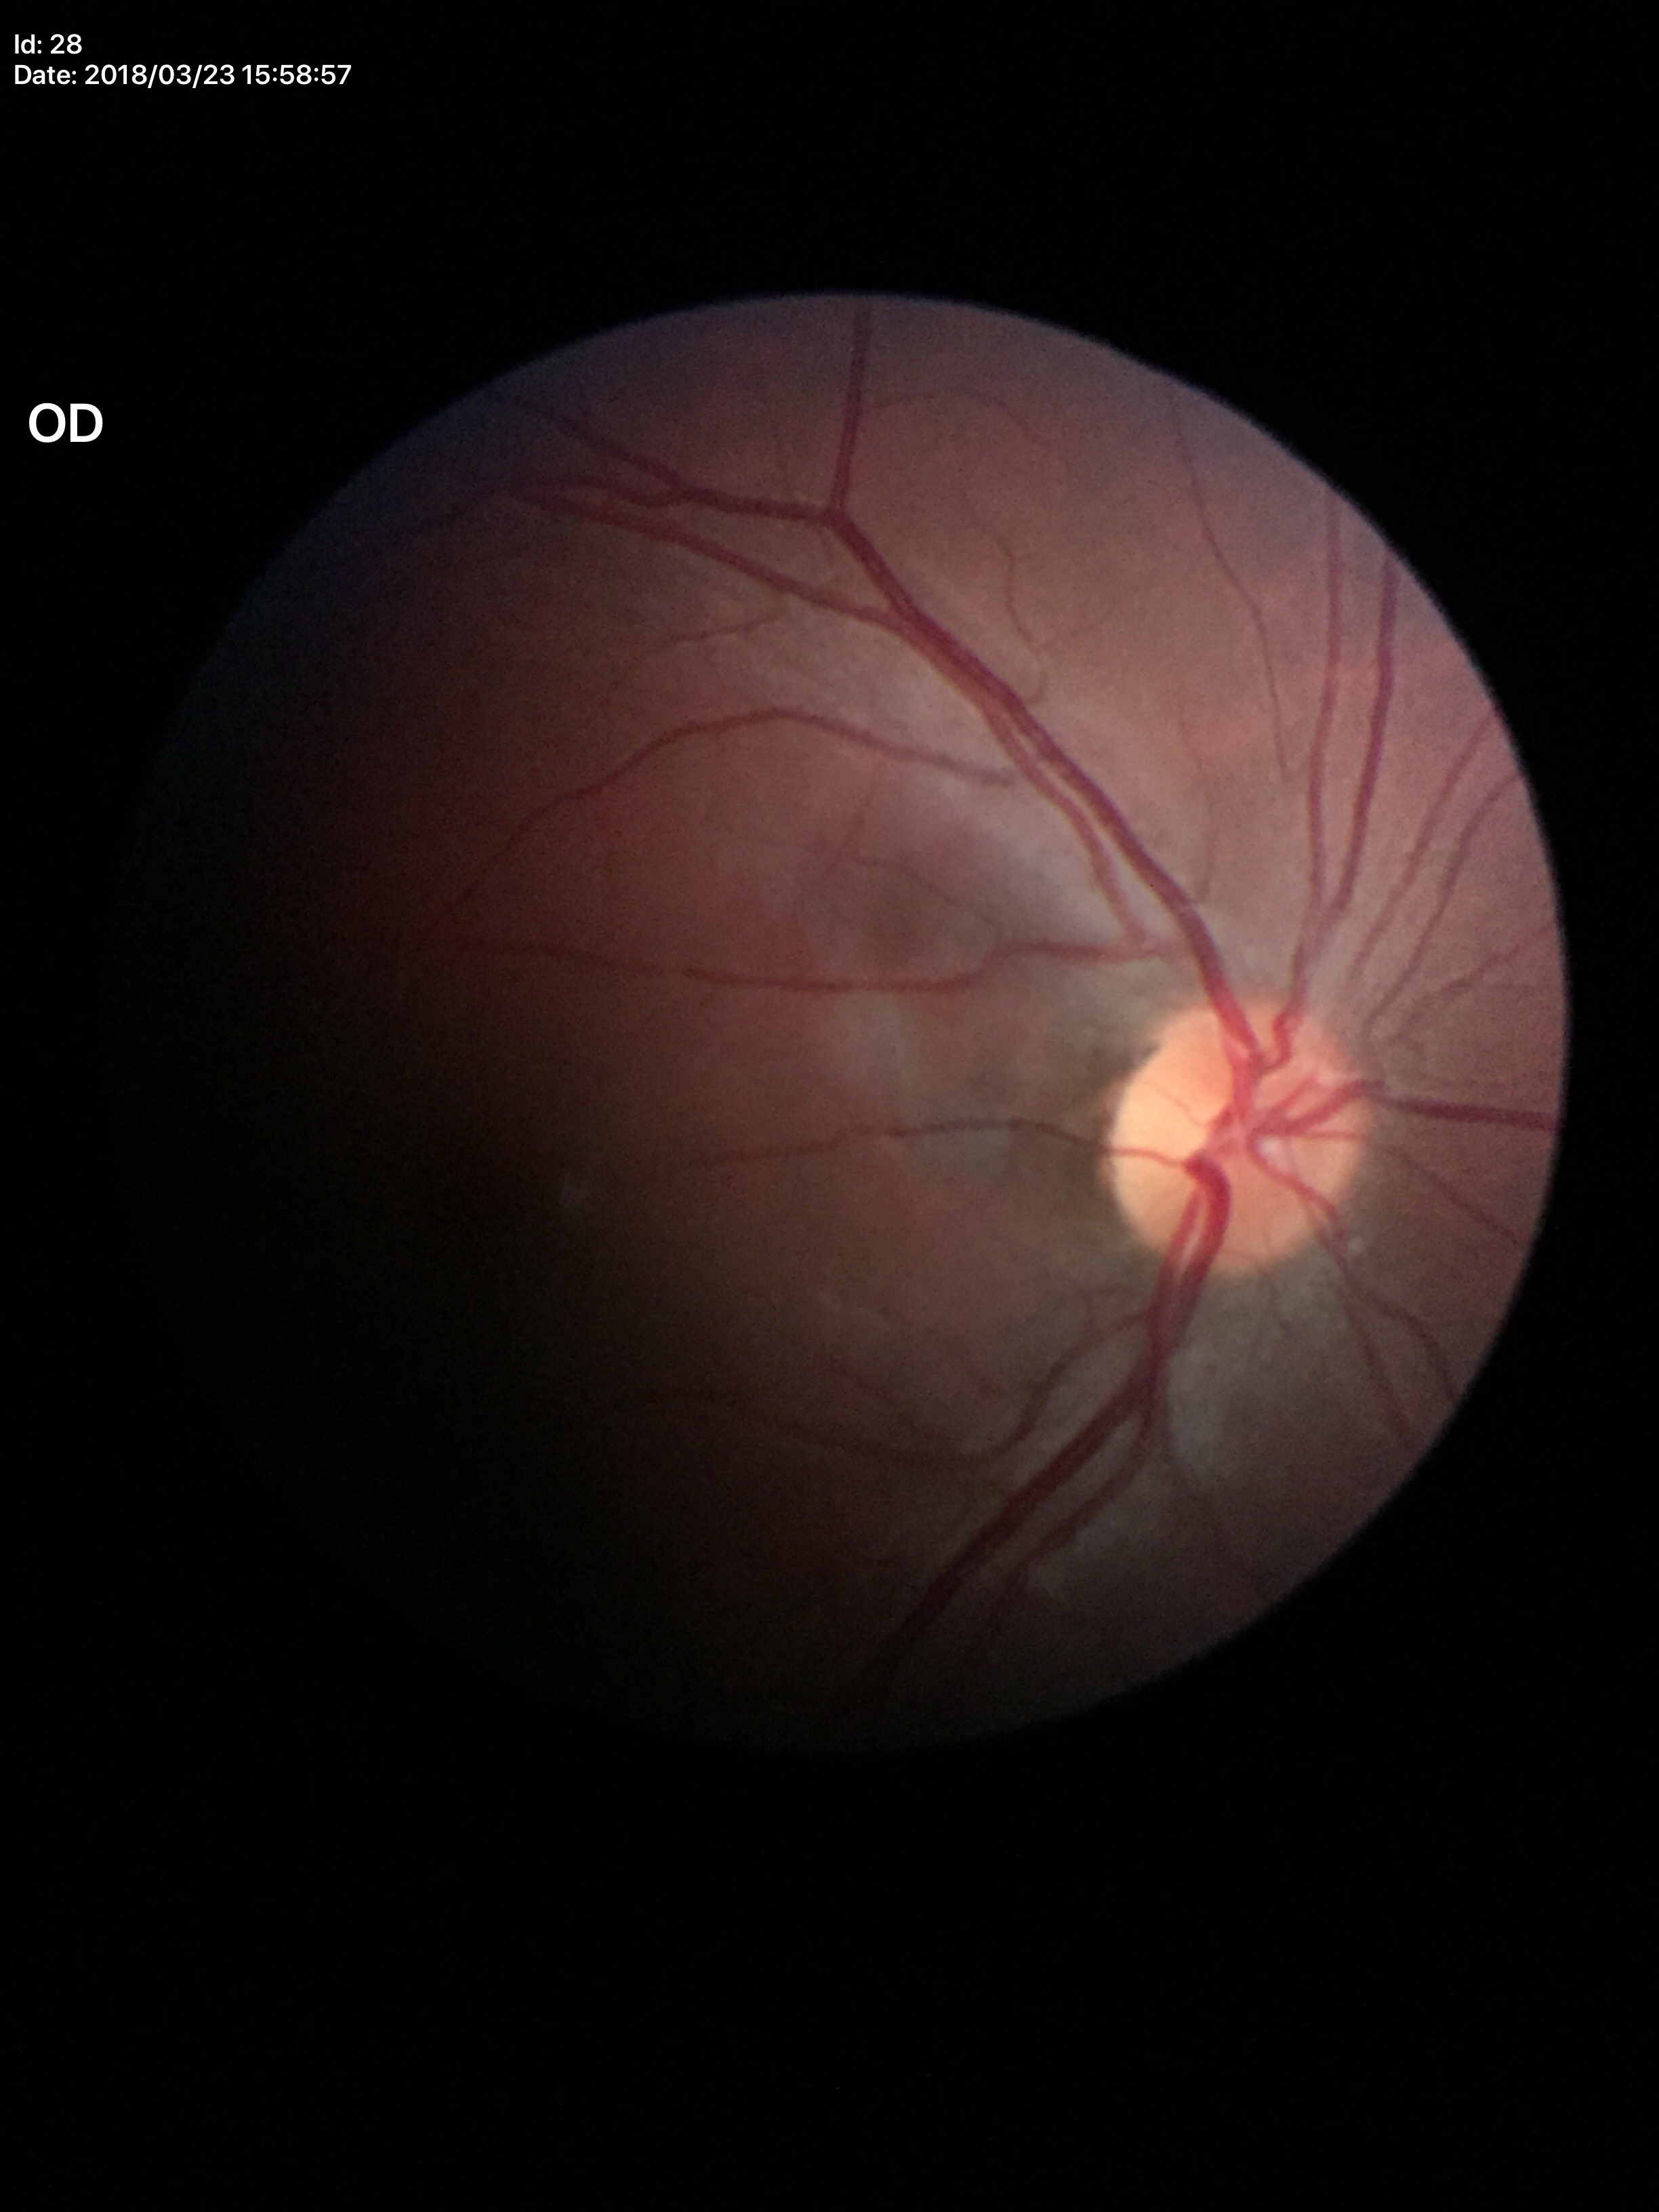

No glaucomatous optic neuropathy.
Horizontal cup-disc ratio (HCDR): 0.46.
Vertical cup-disc ratio (VCDR) is 0.41.